1240 by 1240 pixels; captured with the Phoenix ICON (100° field of view); pediatric wide-field fundus photograph — 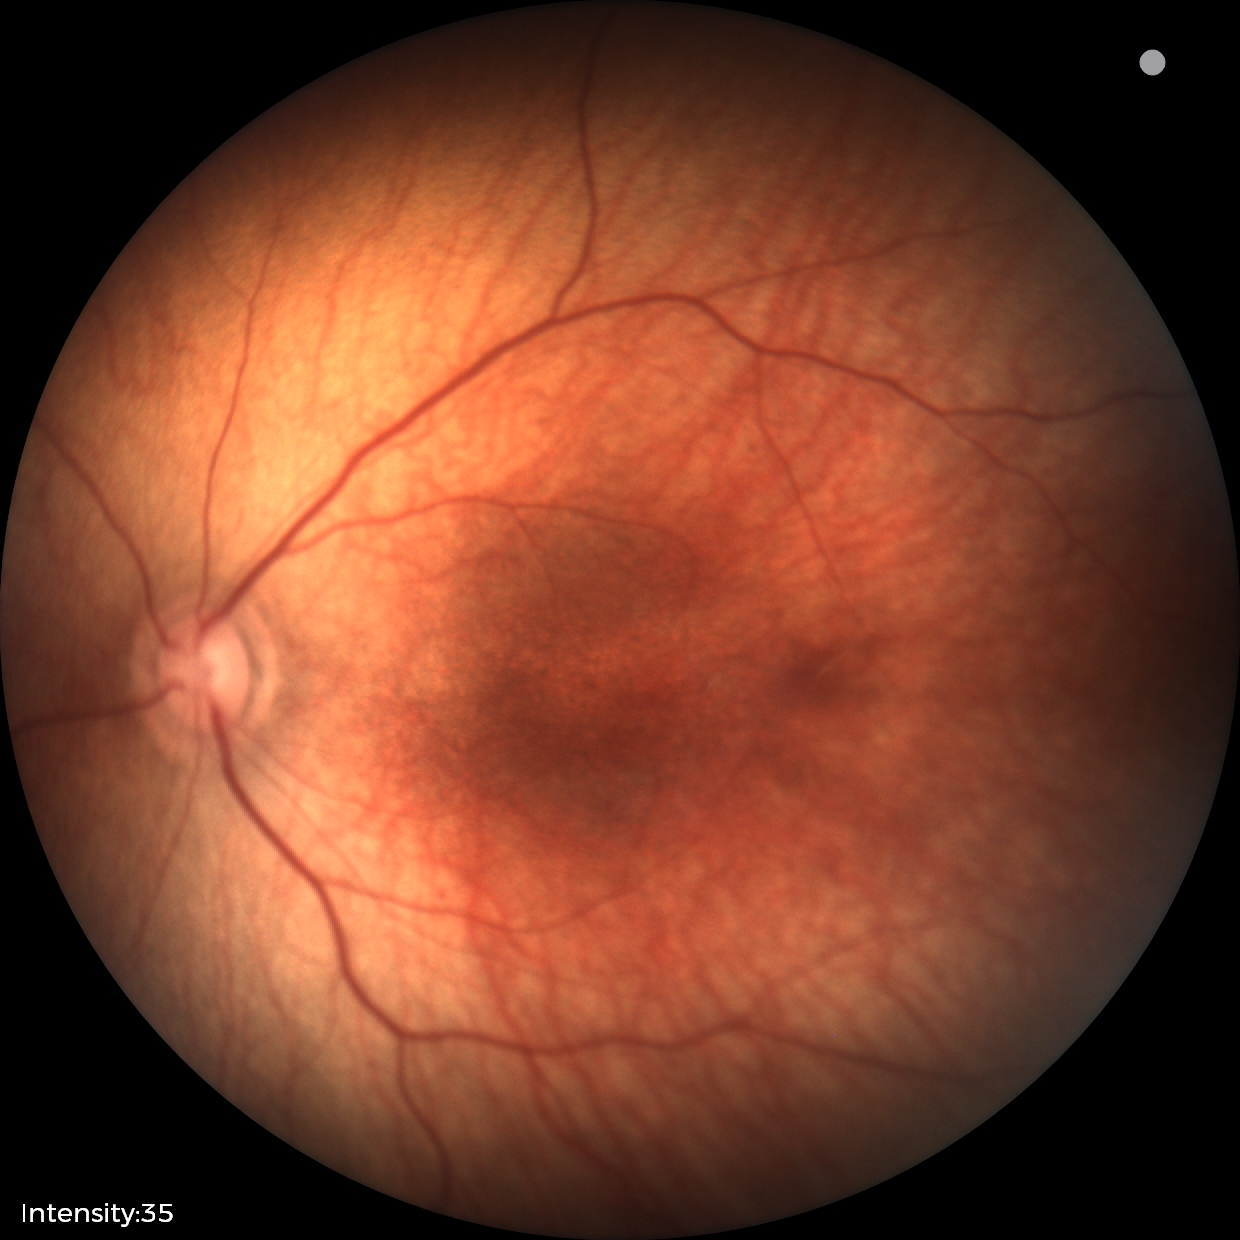

Normal screening examination.